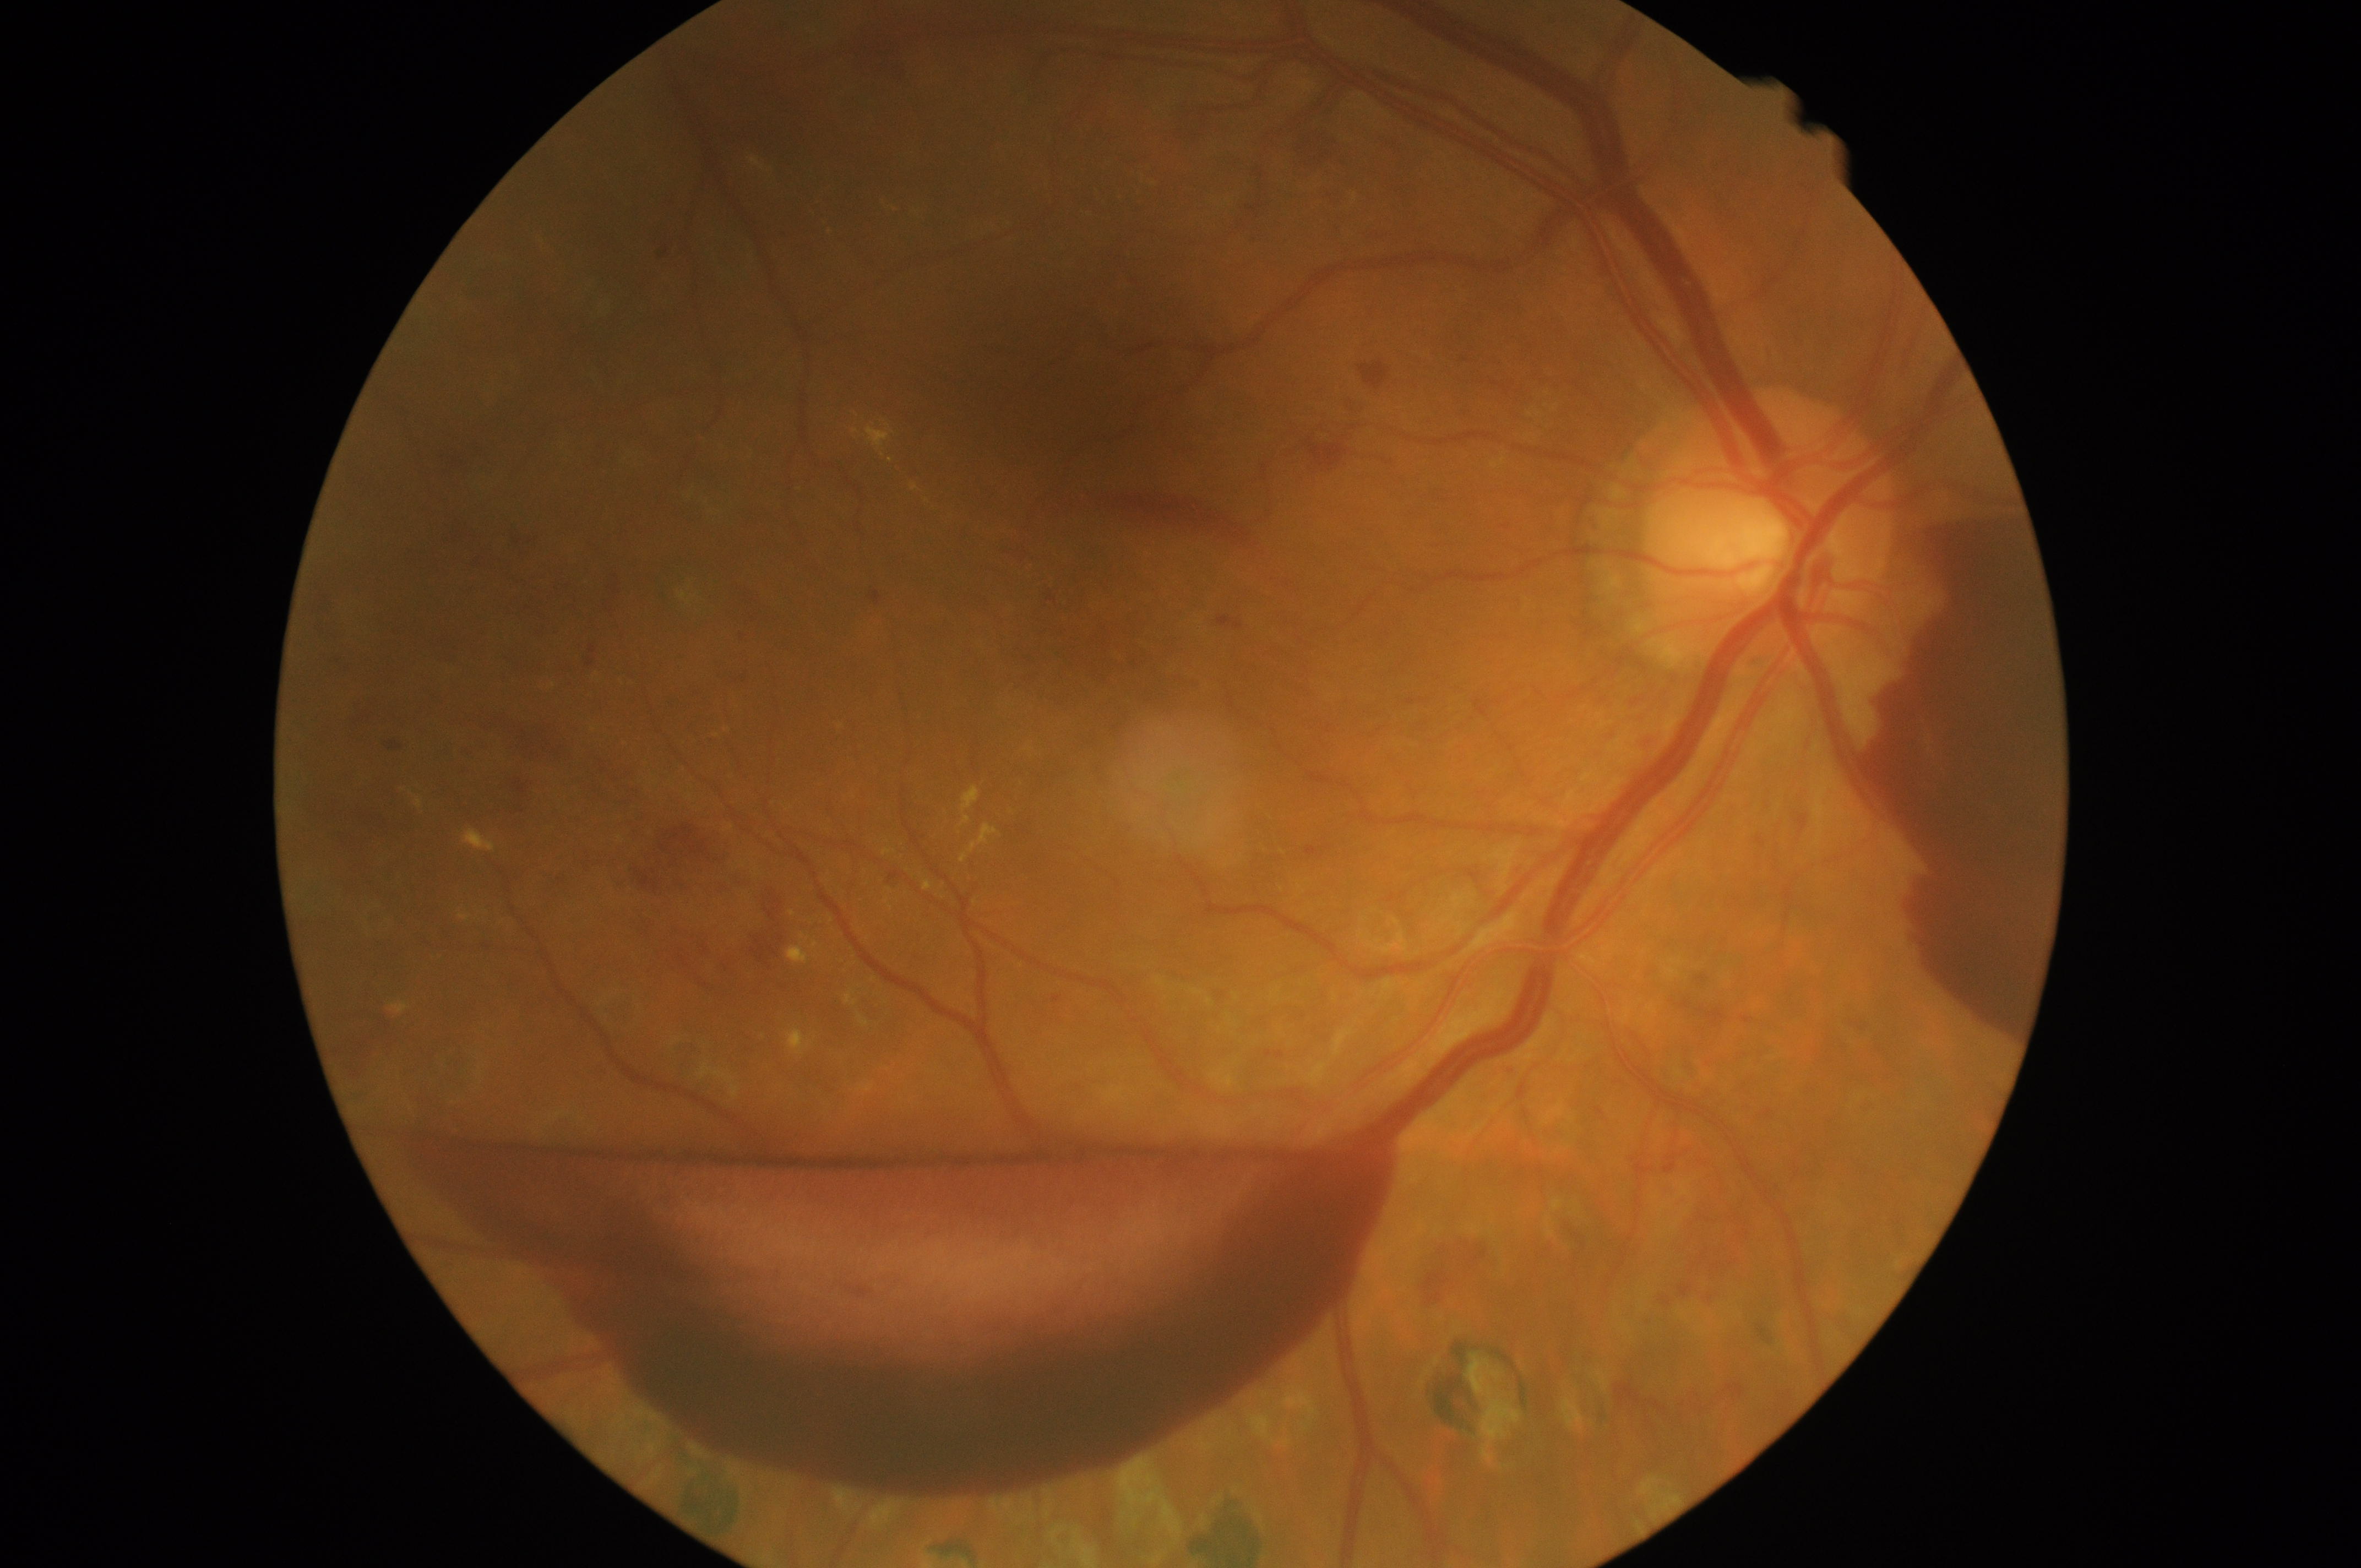
Disease class: proliferative diabetic retinopathy. DR stage: grade 4 (PDR).